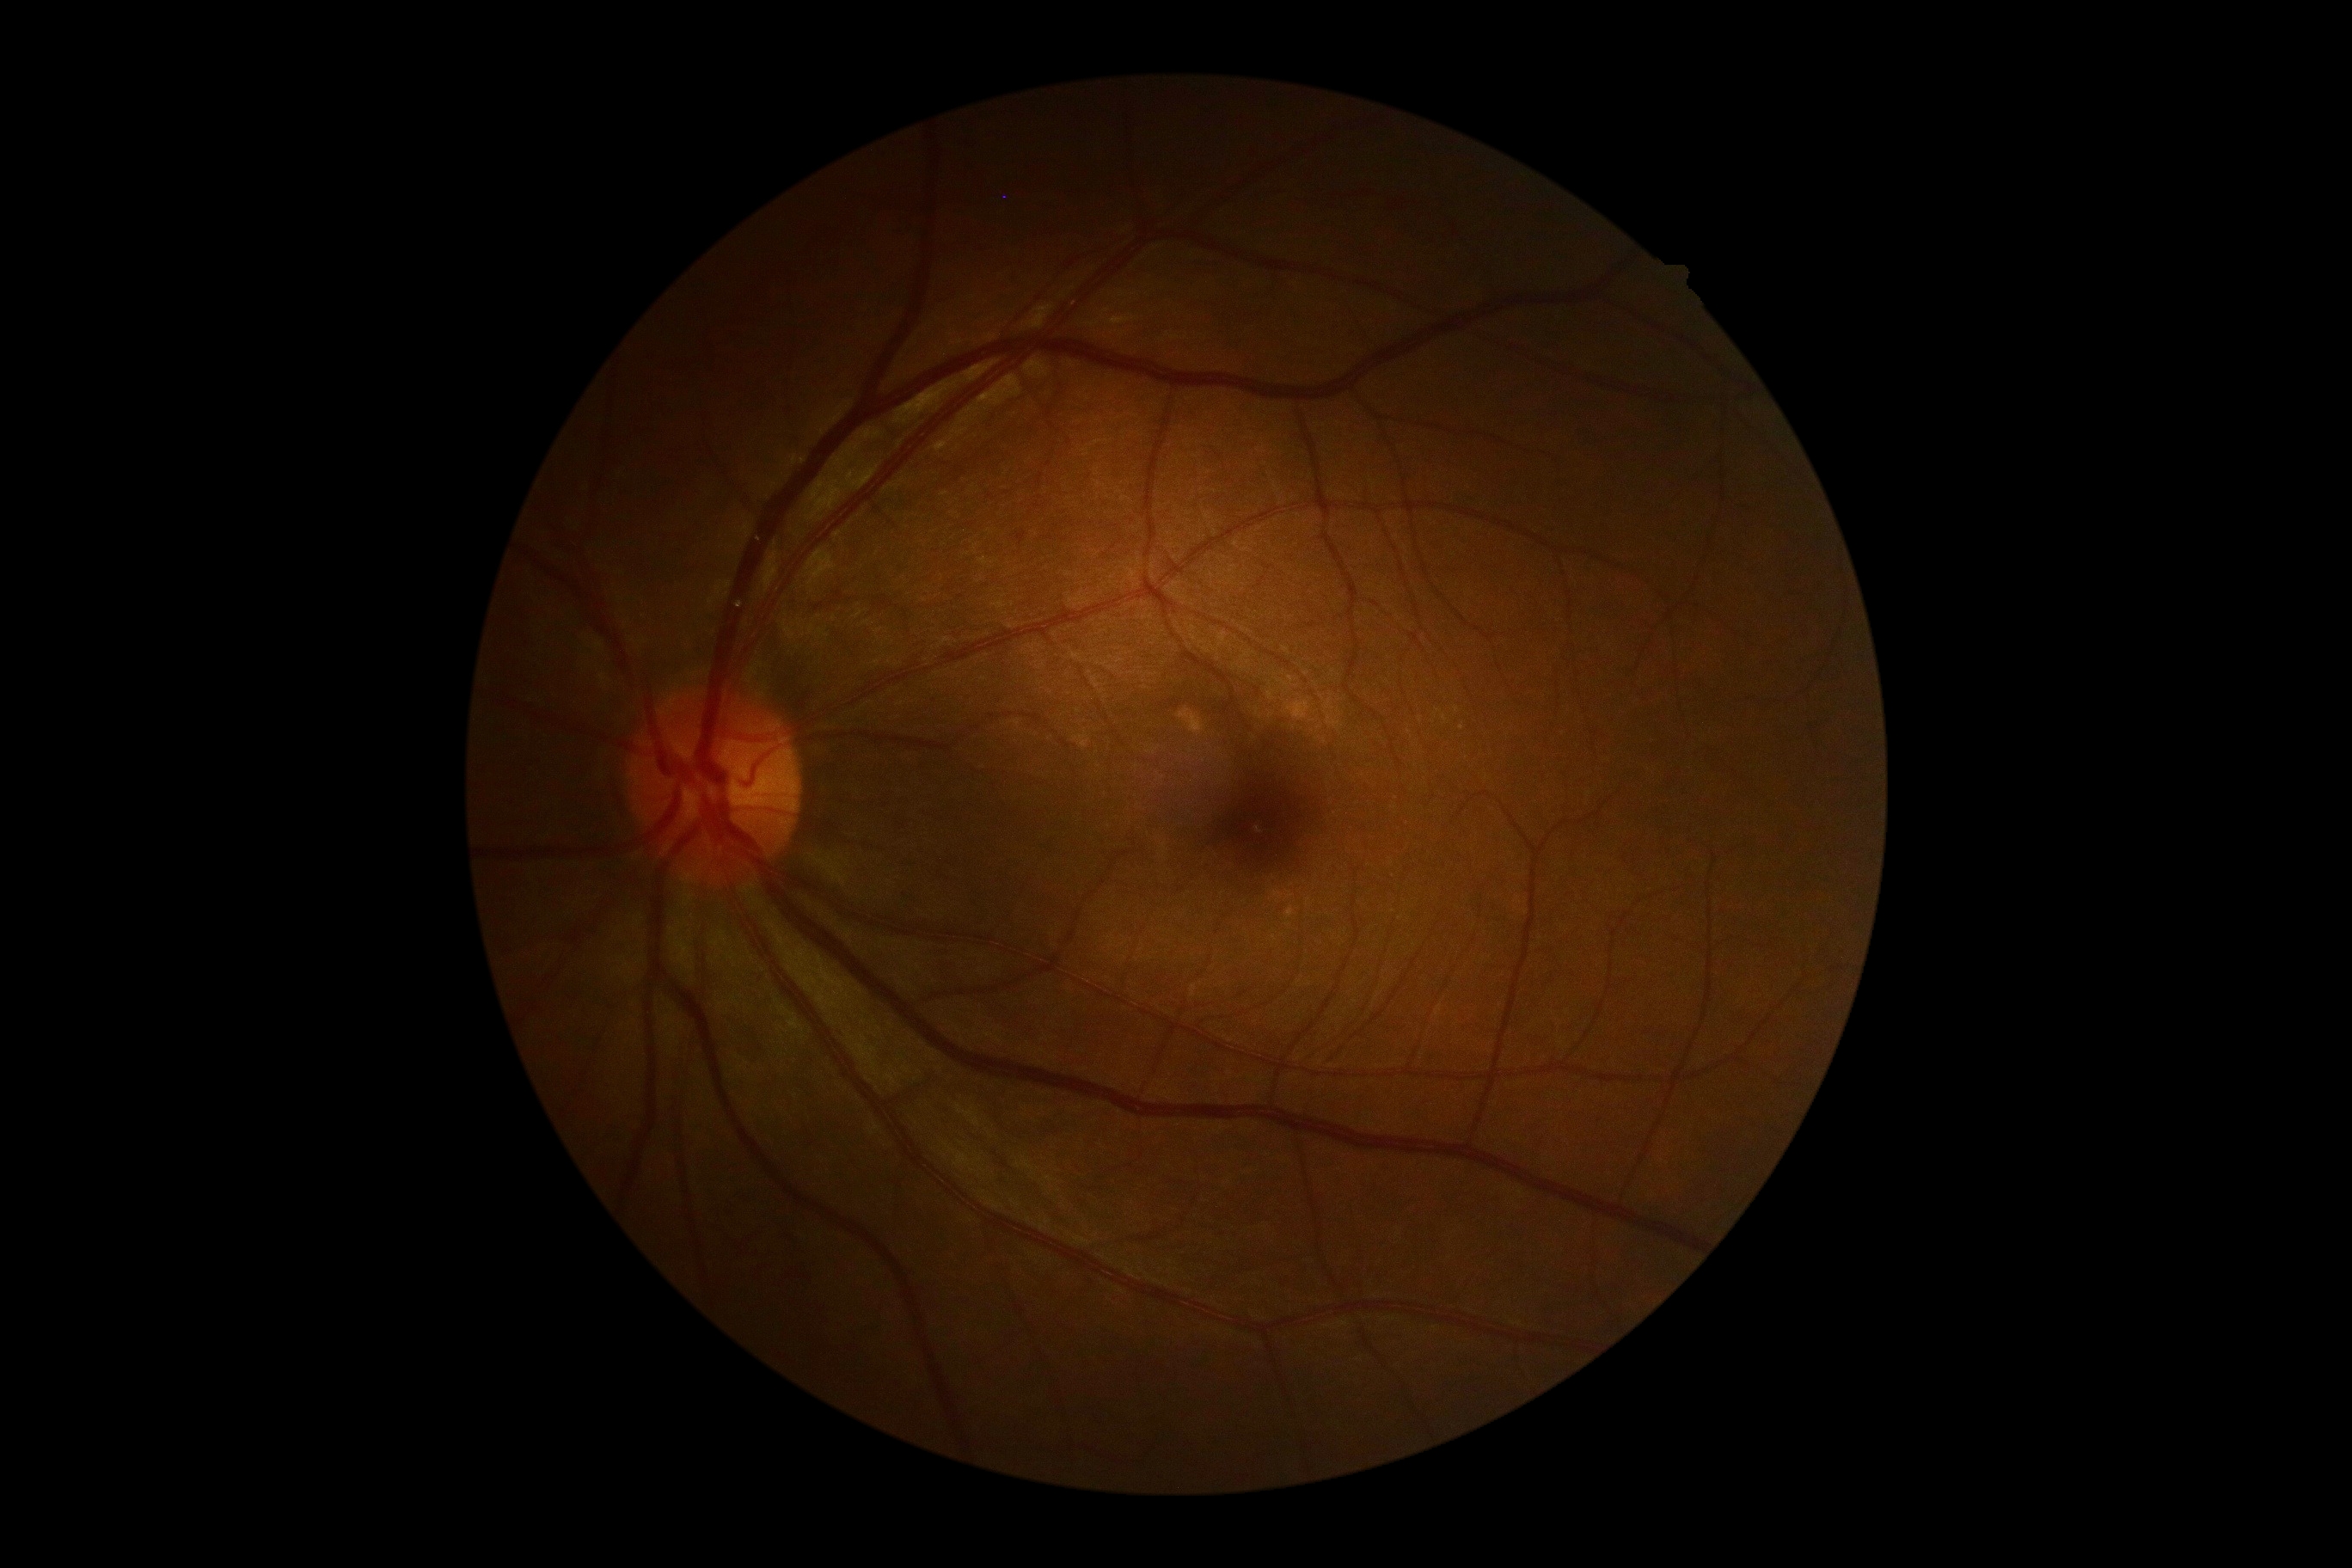 Diabetic retinopathy is no apparent diabetic retinopathy (grade 0).